2212 x 1659 pixels — 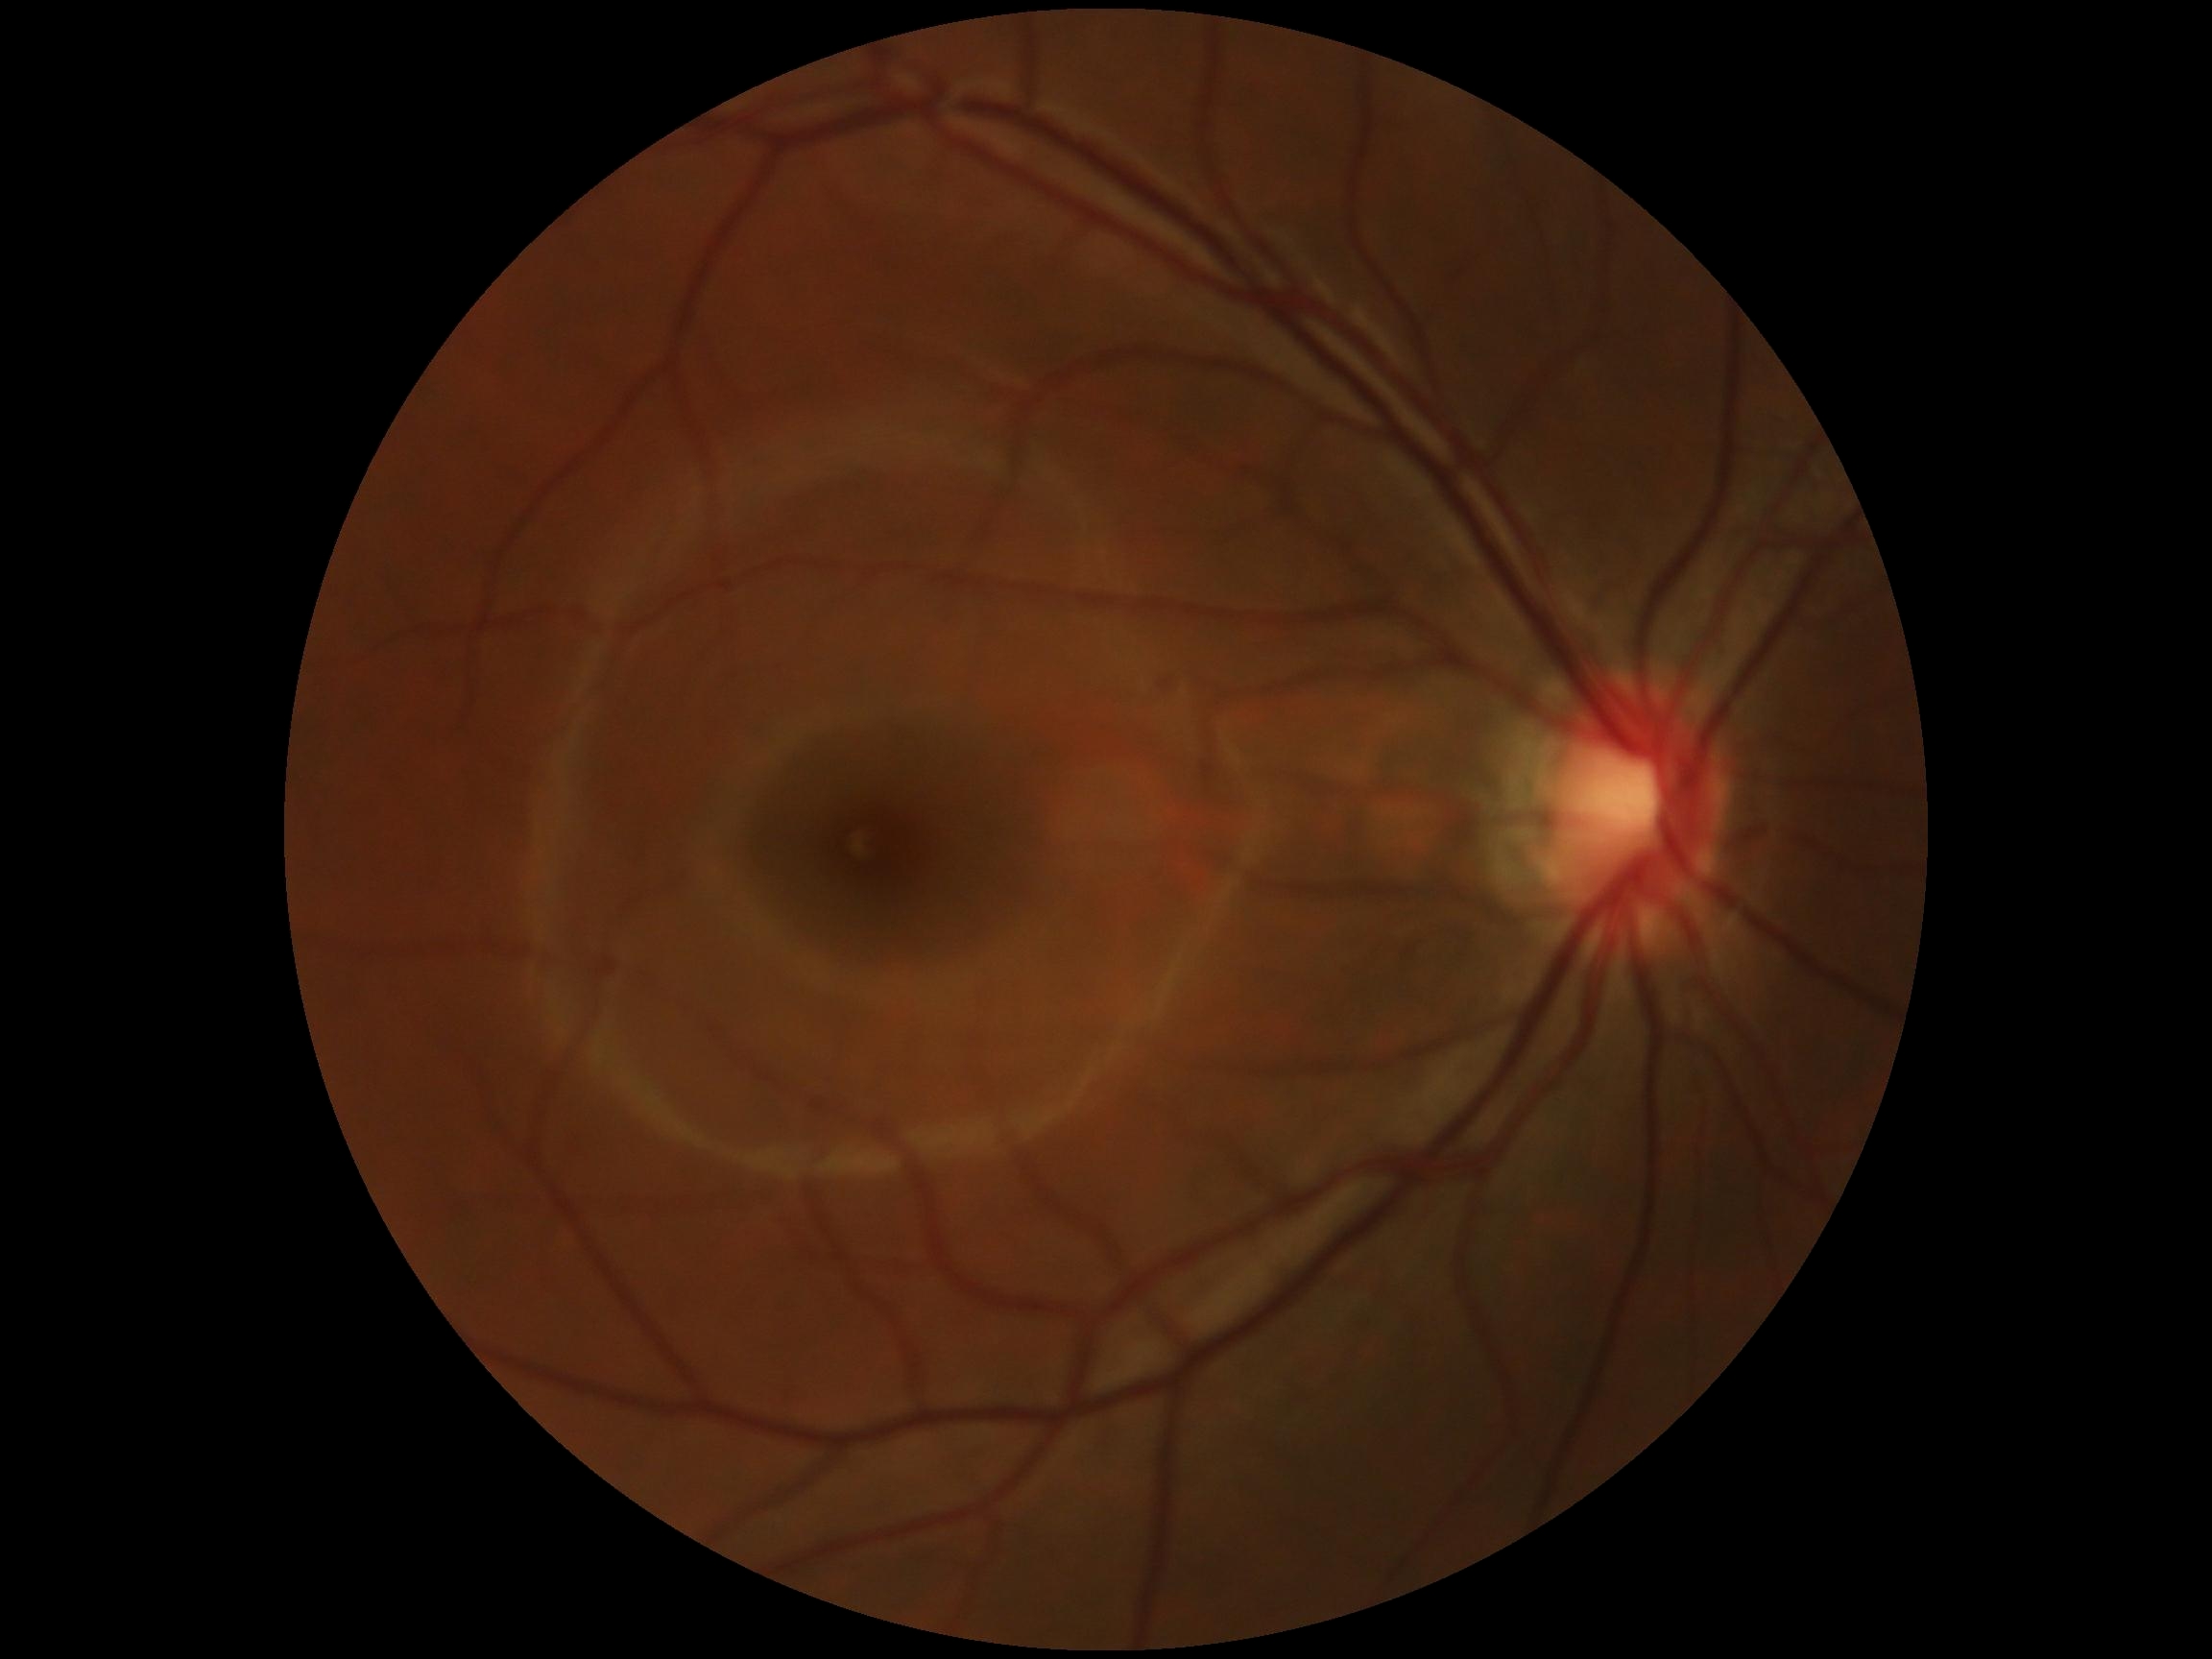 DR stage is 0/4.